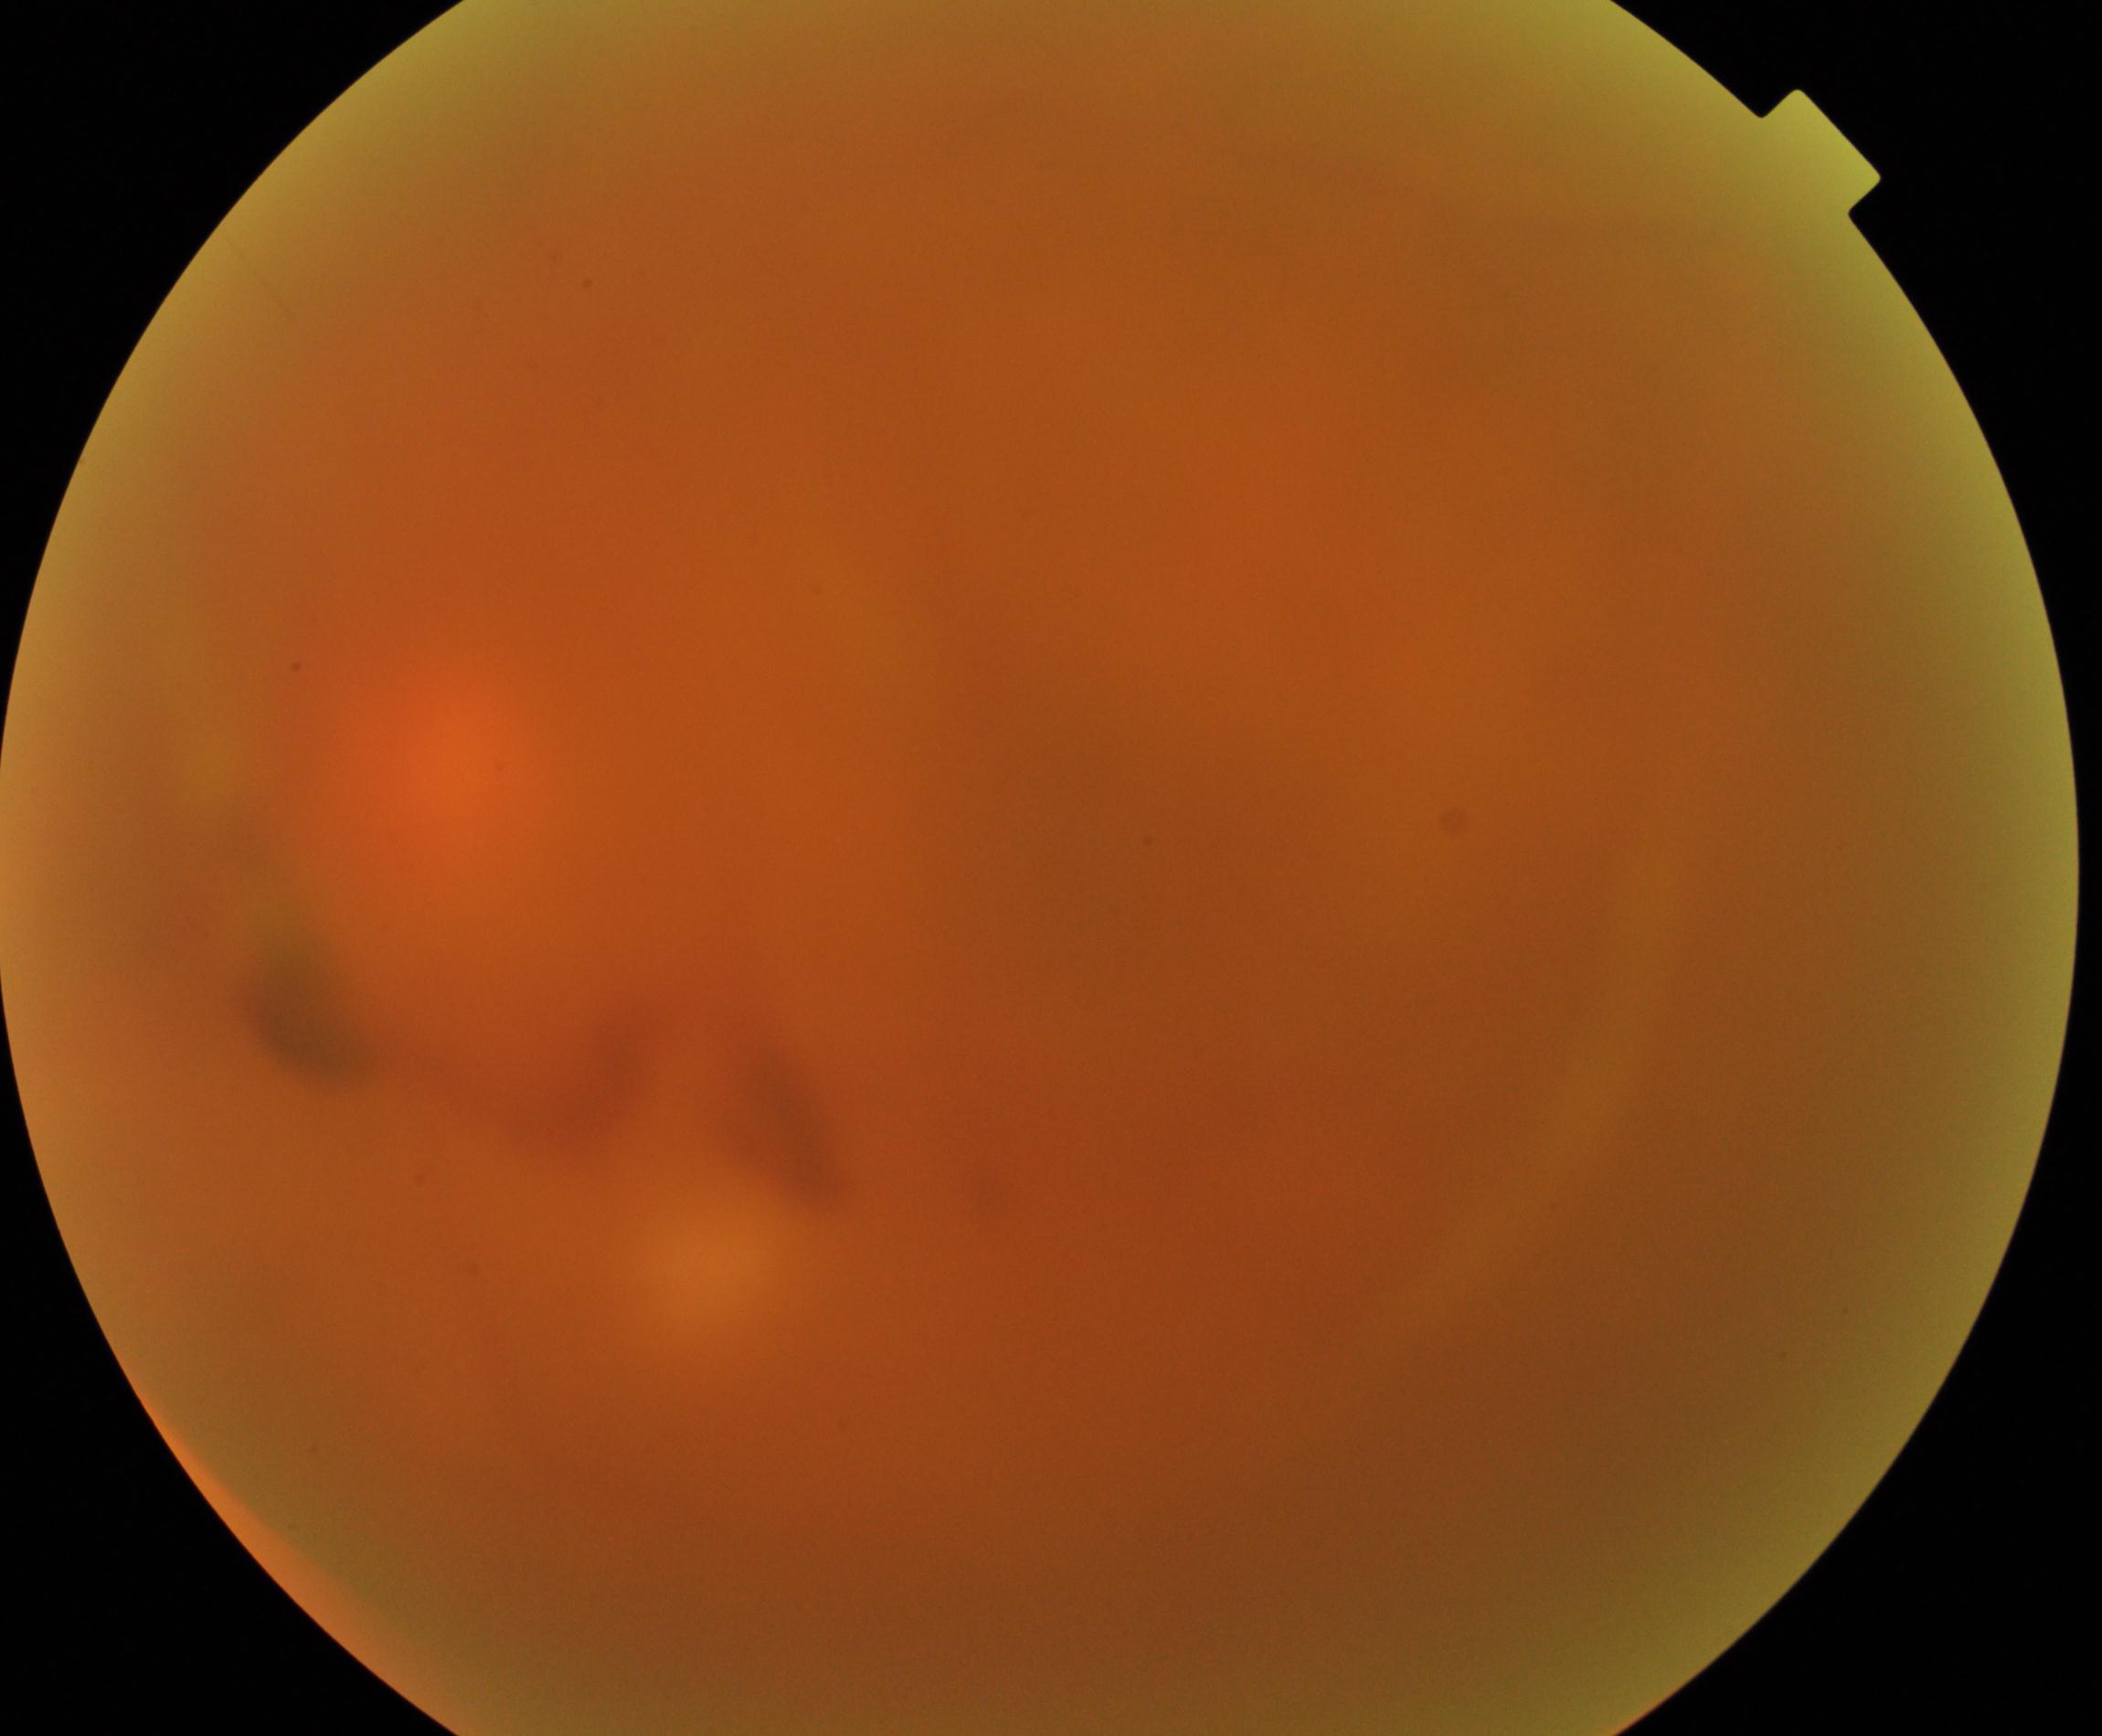
Significantly degraded image quality with obscured retinal detail. Features suspicious for proliferative diabetic retinopathy.